Retinal fundus photograph; FOV: 45 degrees: 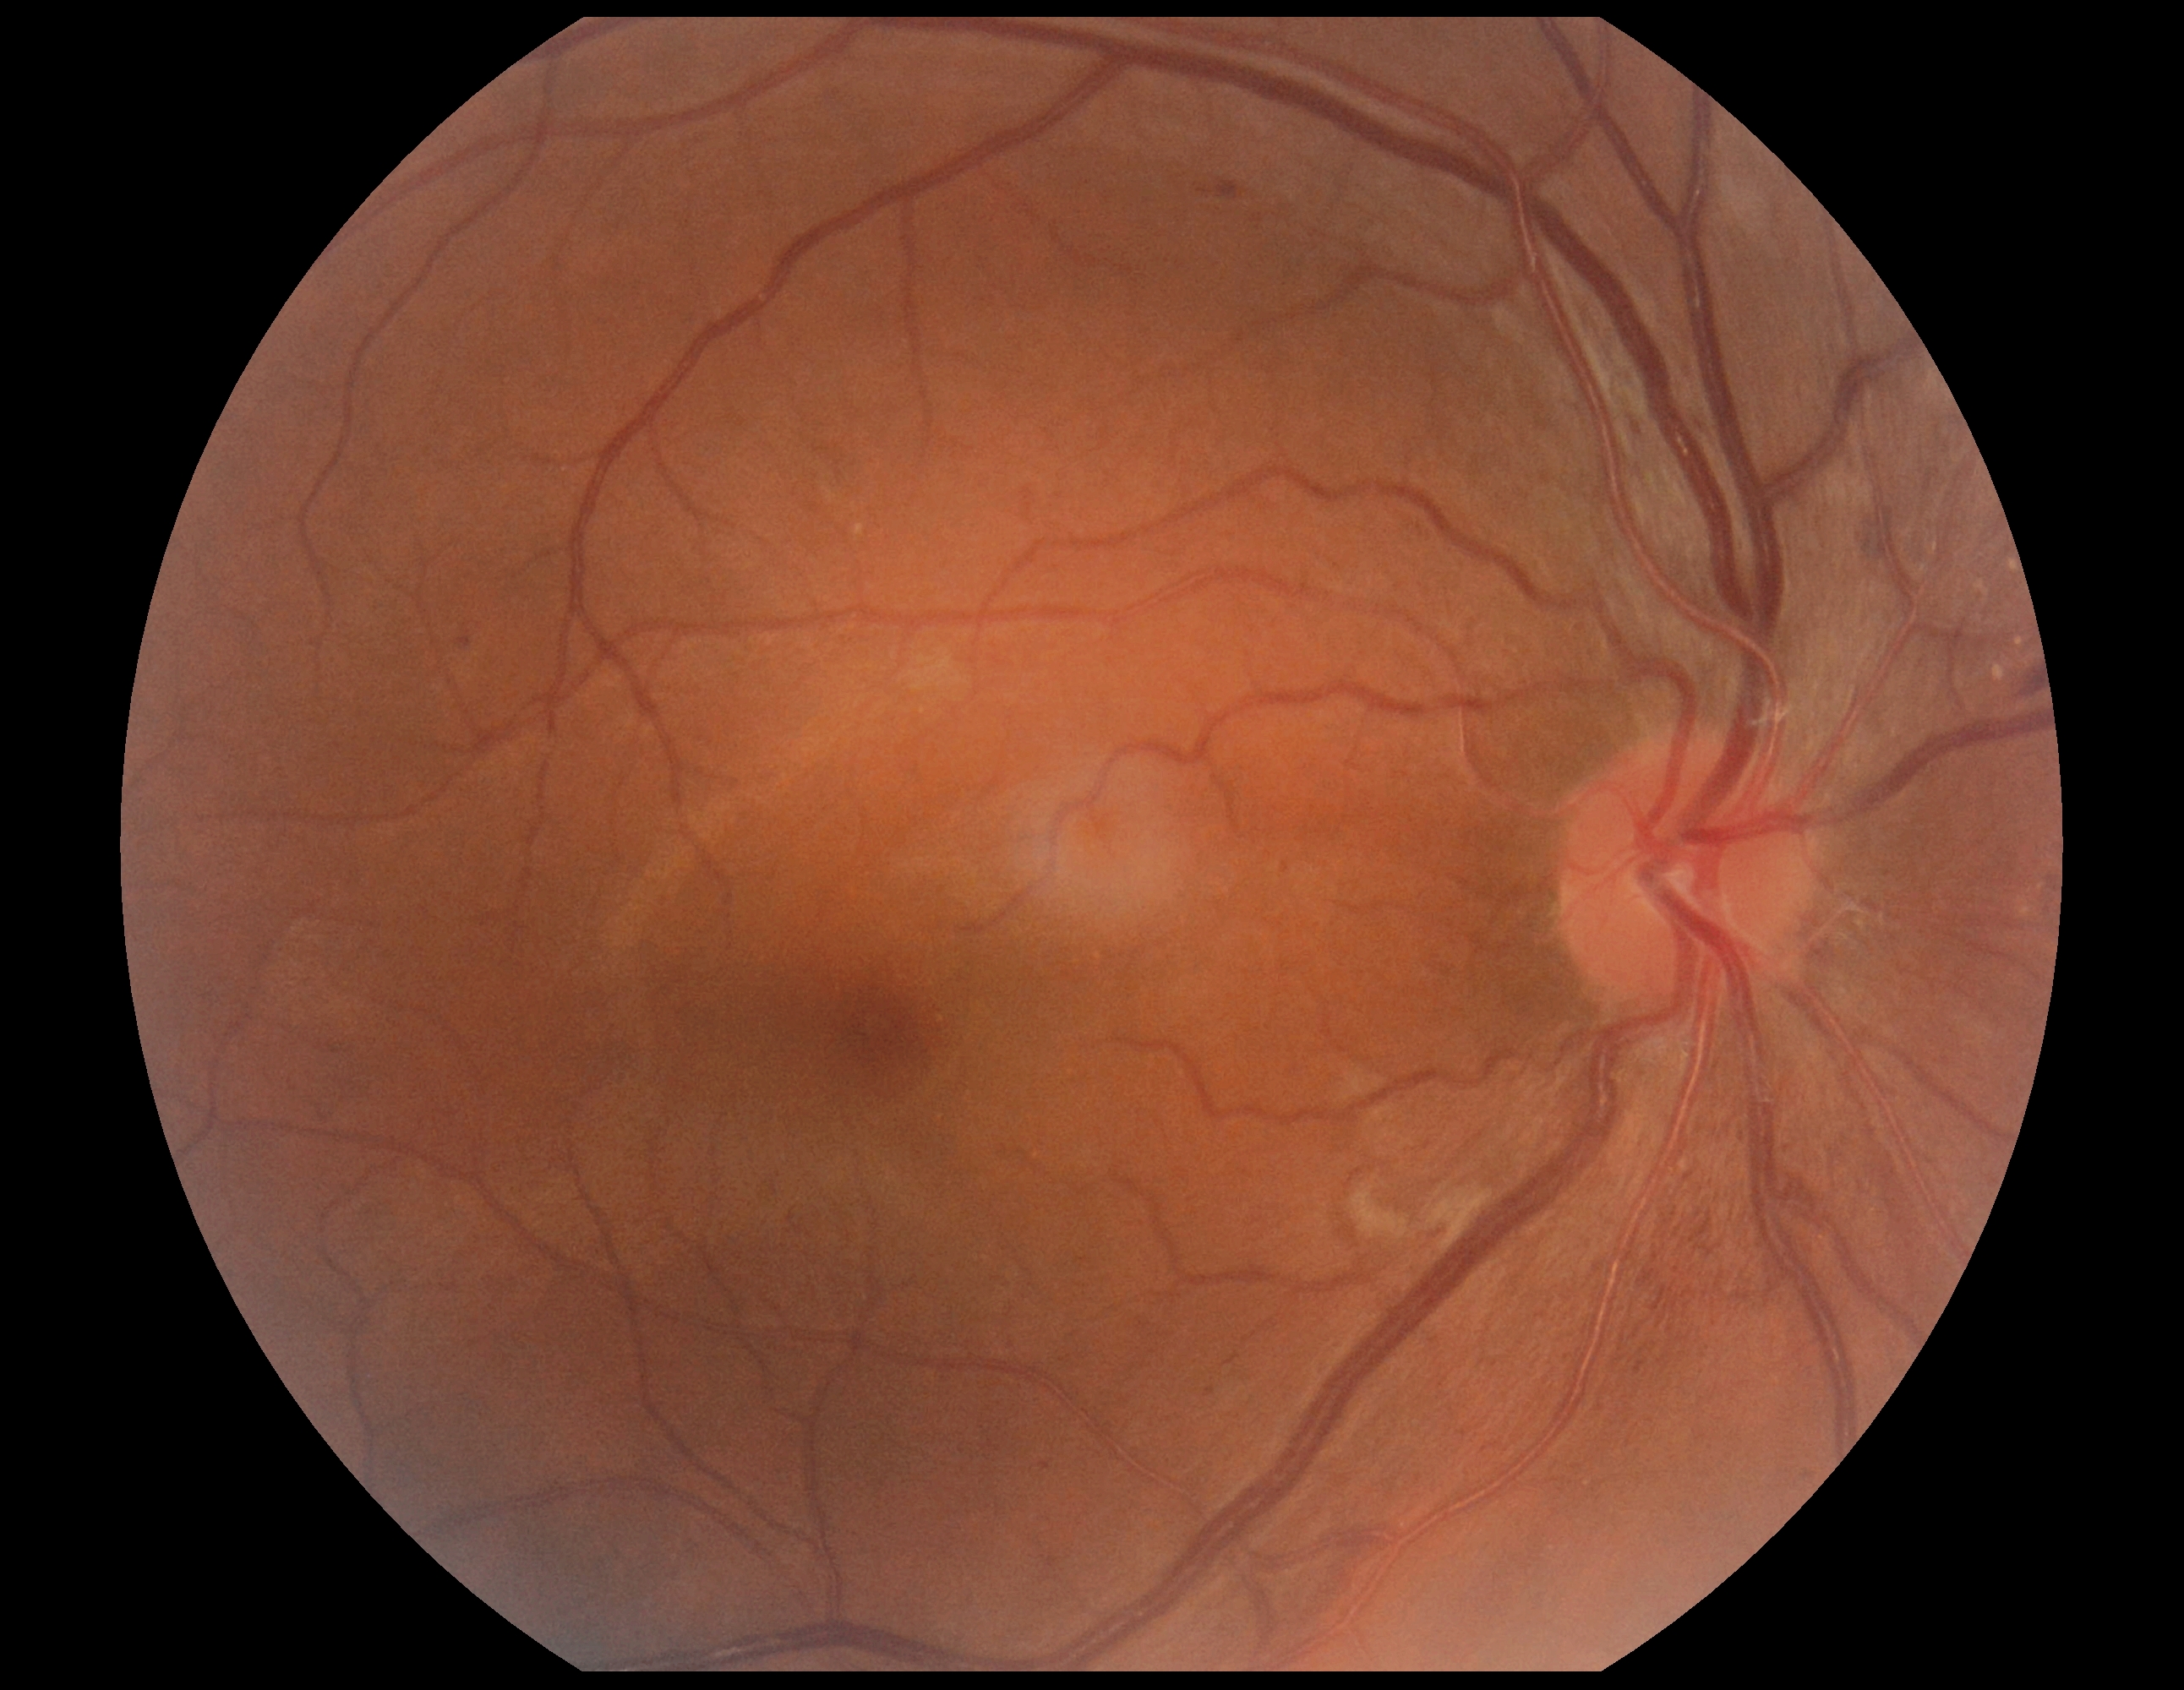 Diabetic retinopathy (DR): moderate non-proliferative diabetic retinopathy (grade 2). The retinopathy is classified as non-proliferative diabetic retinopathy.